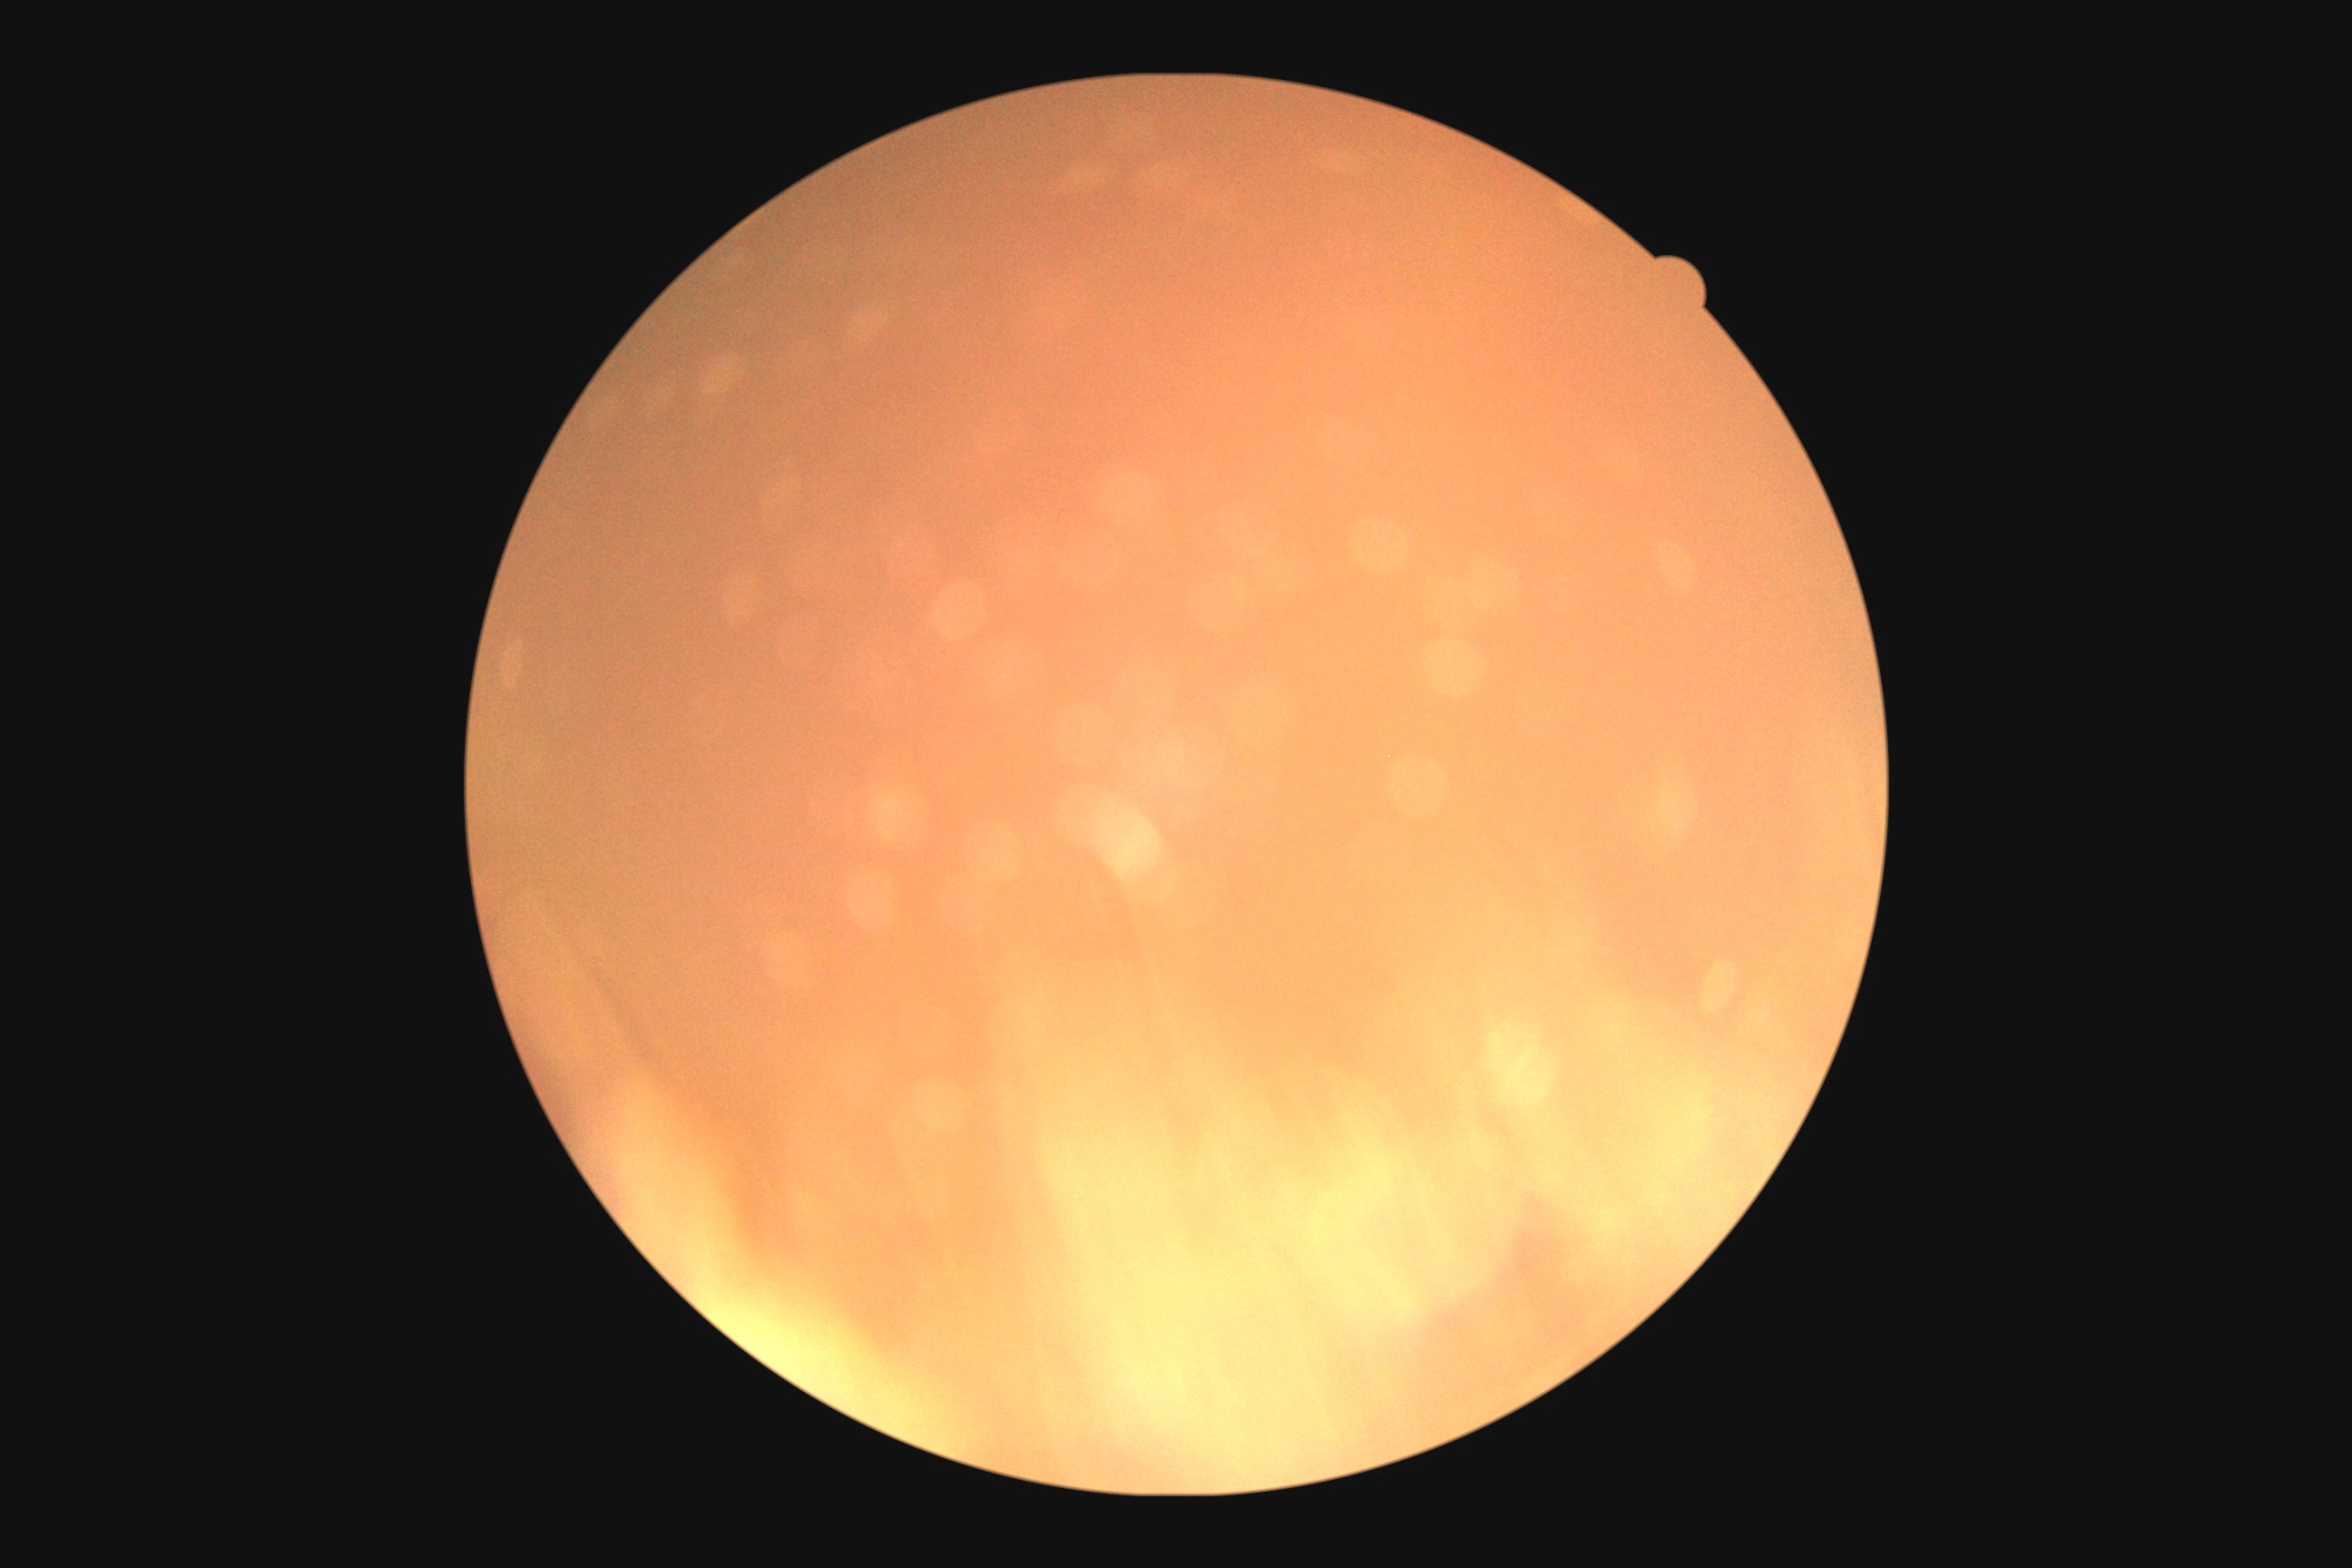

DR grade: ungradable. Ungradable image — DR severity cannot be determined.